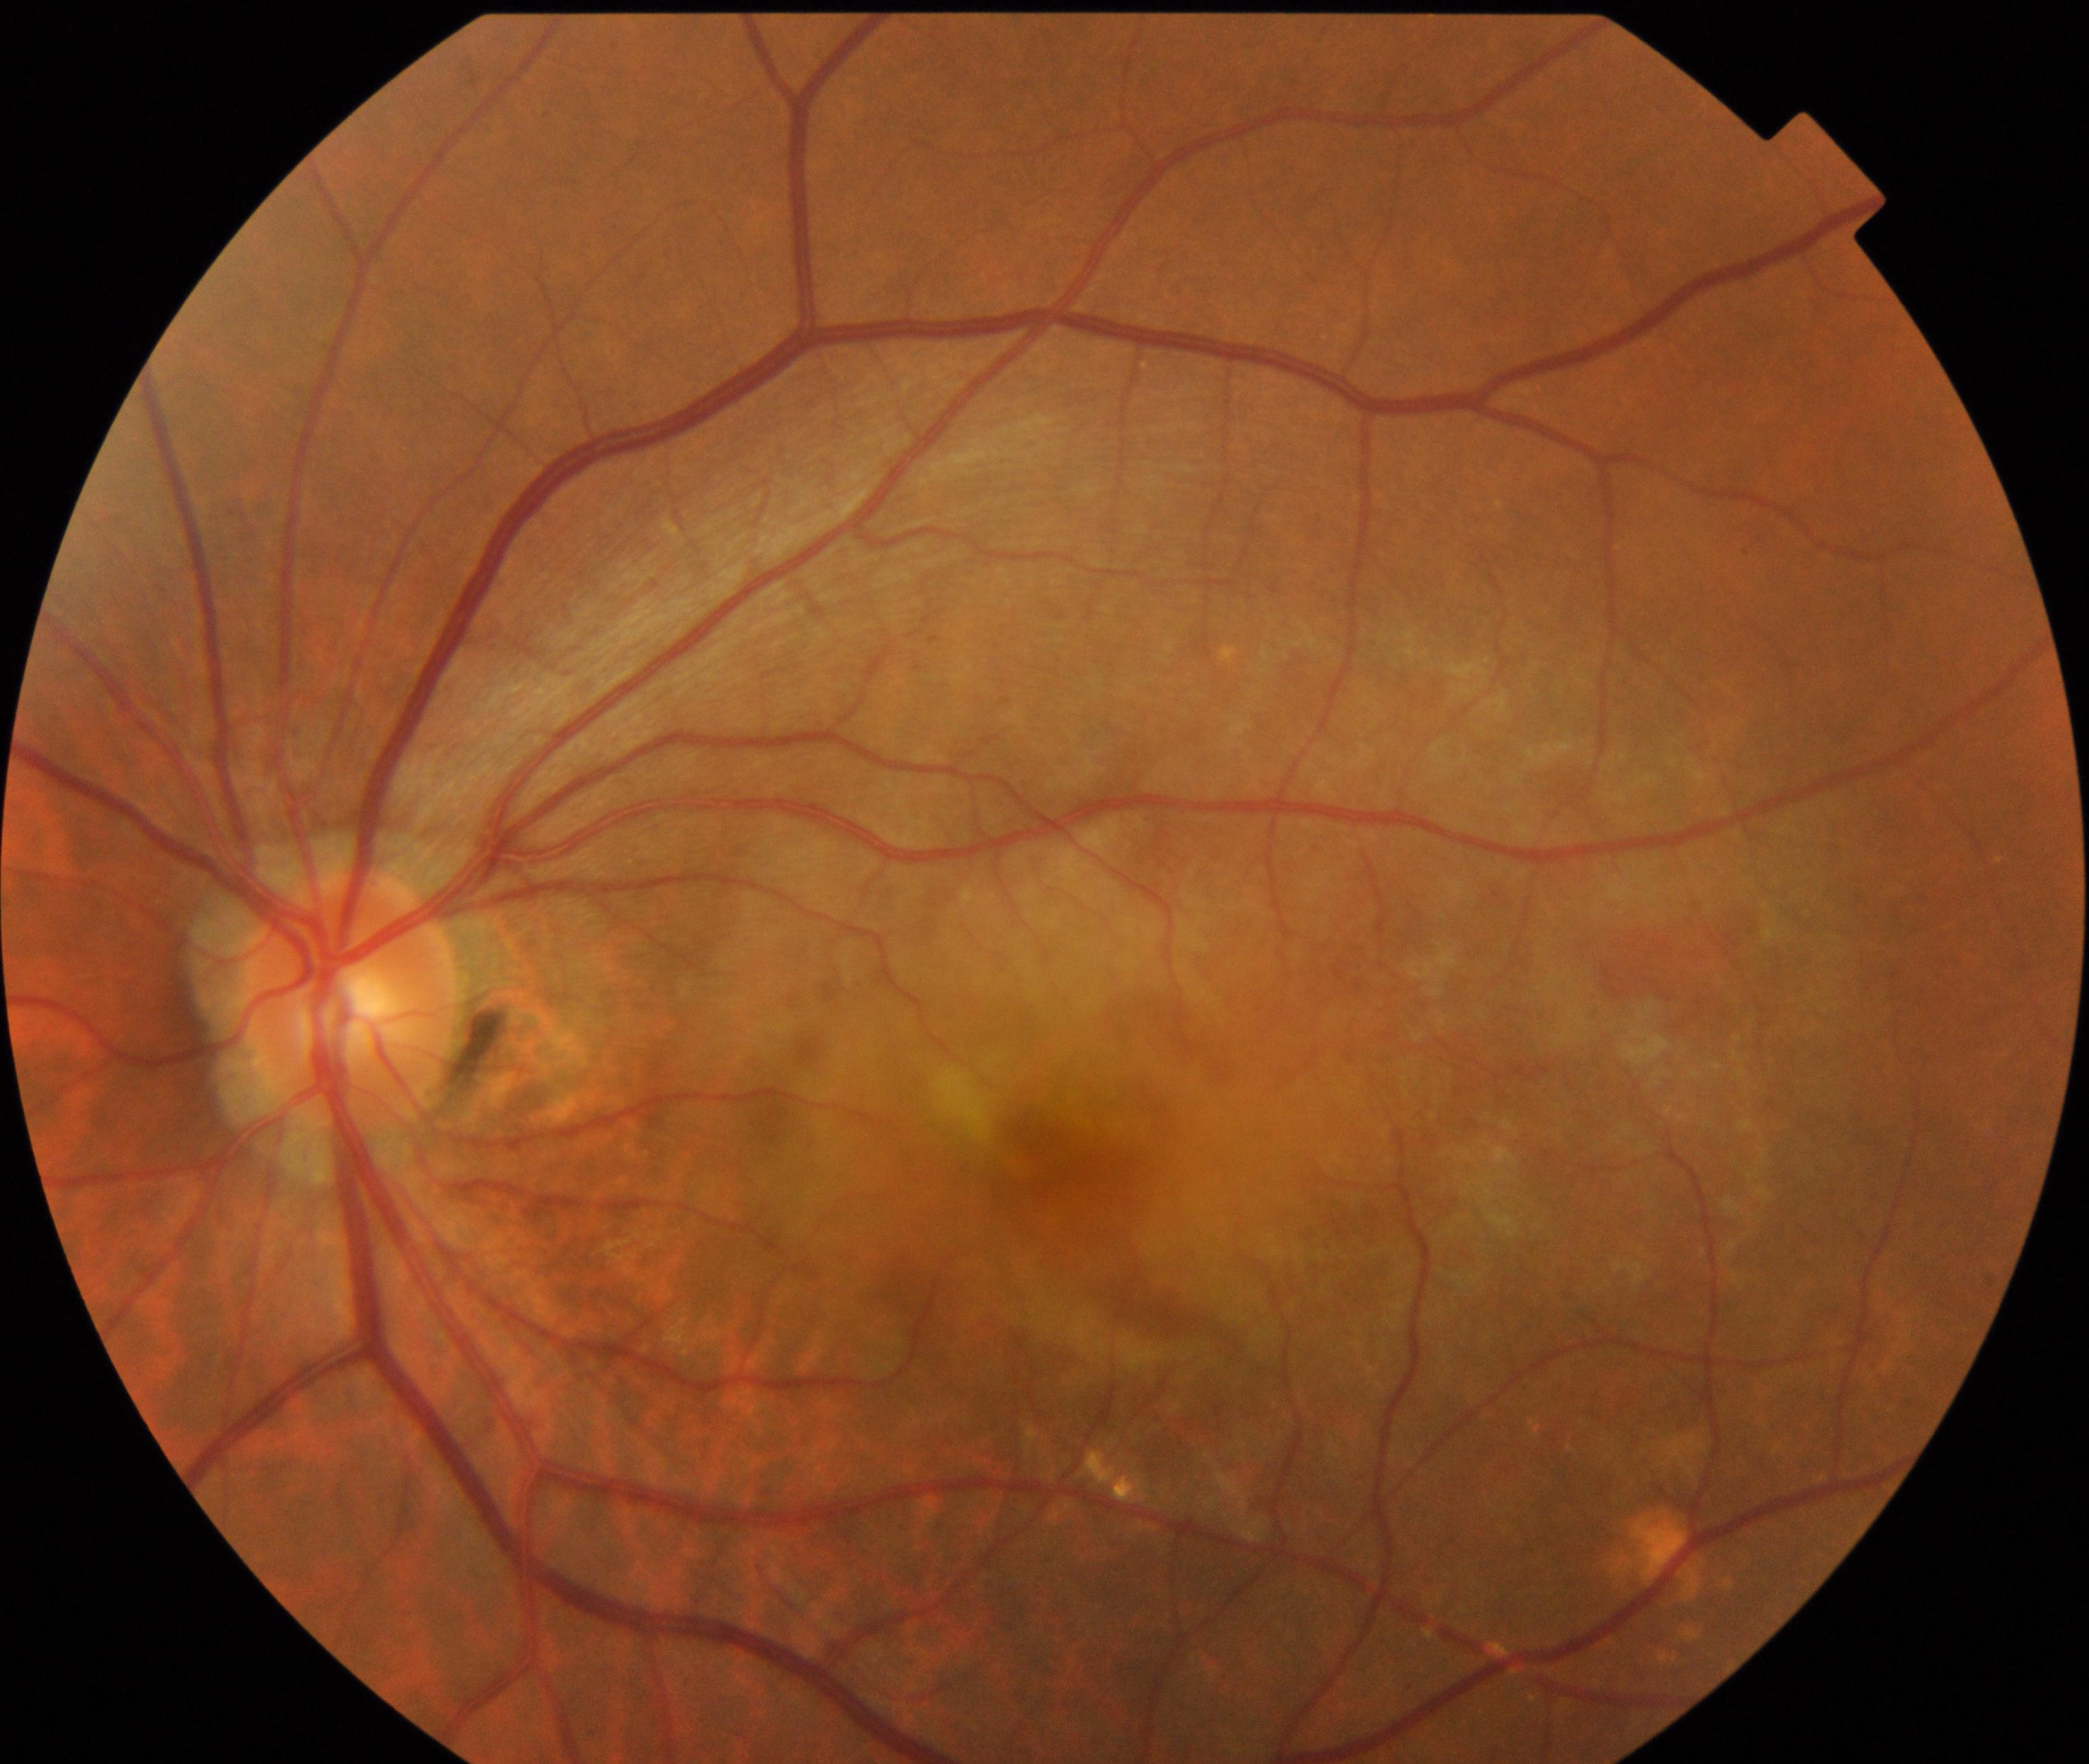 Classification: maculopathy.